Infant wide-field retinal image · Phoenix ICON, 100° FOV:
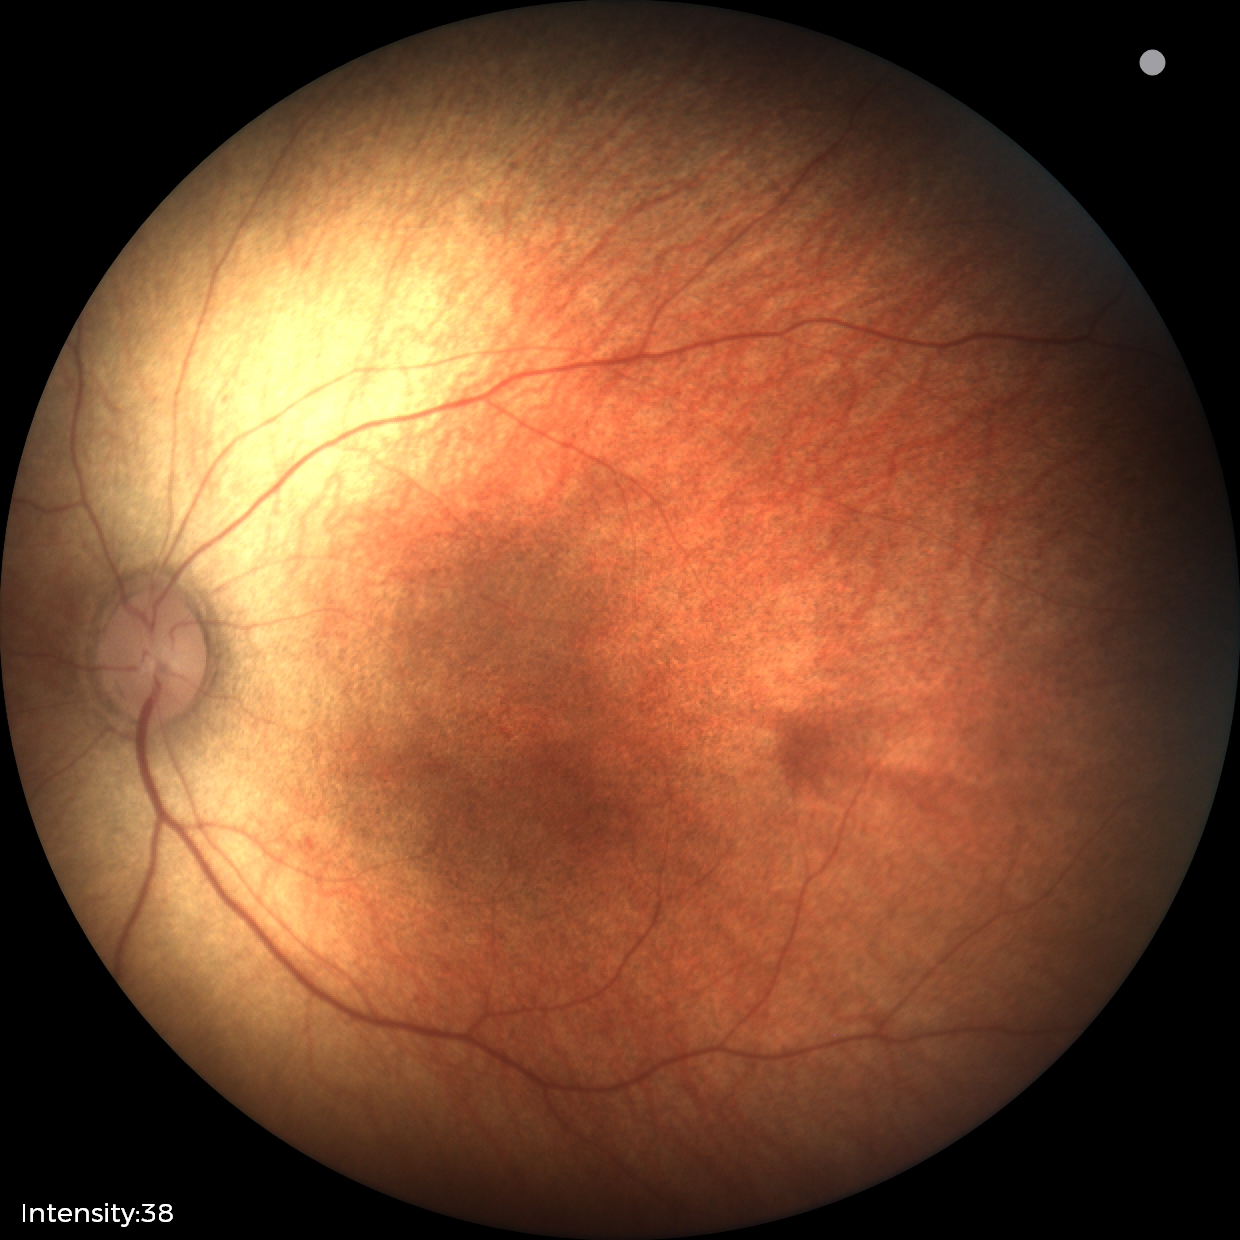

Q: What is the diagnosis from this examination?
A: no abnormal retinal findings